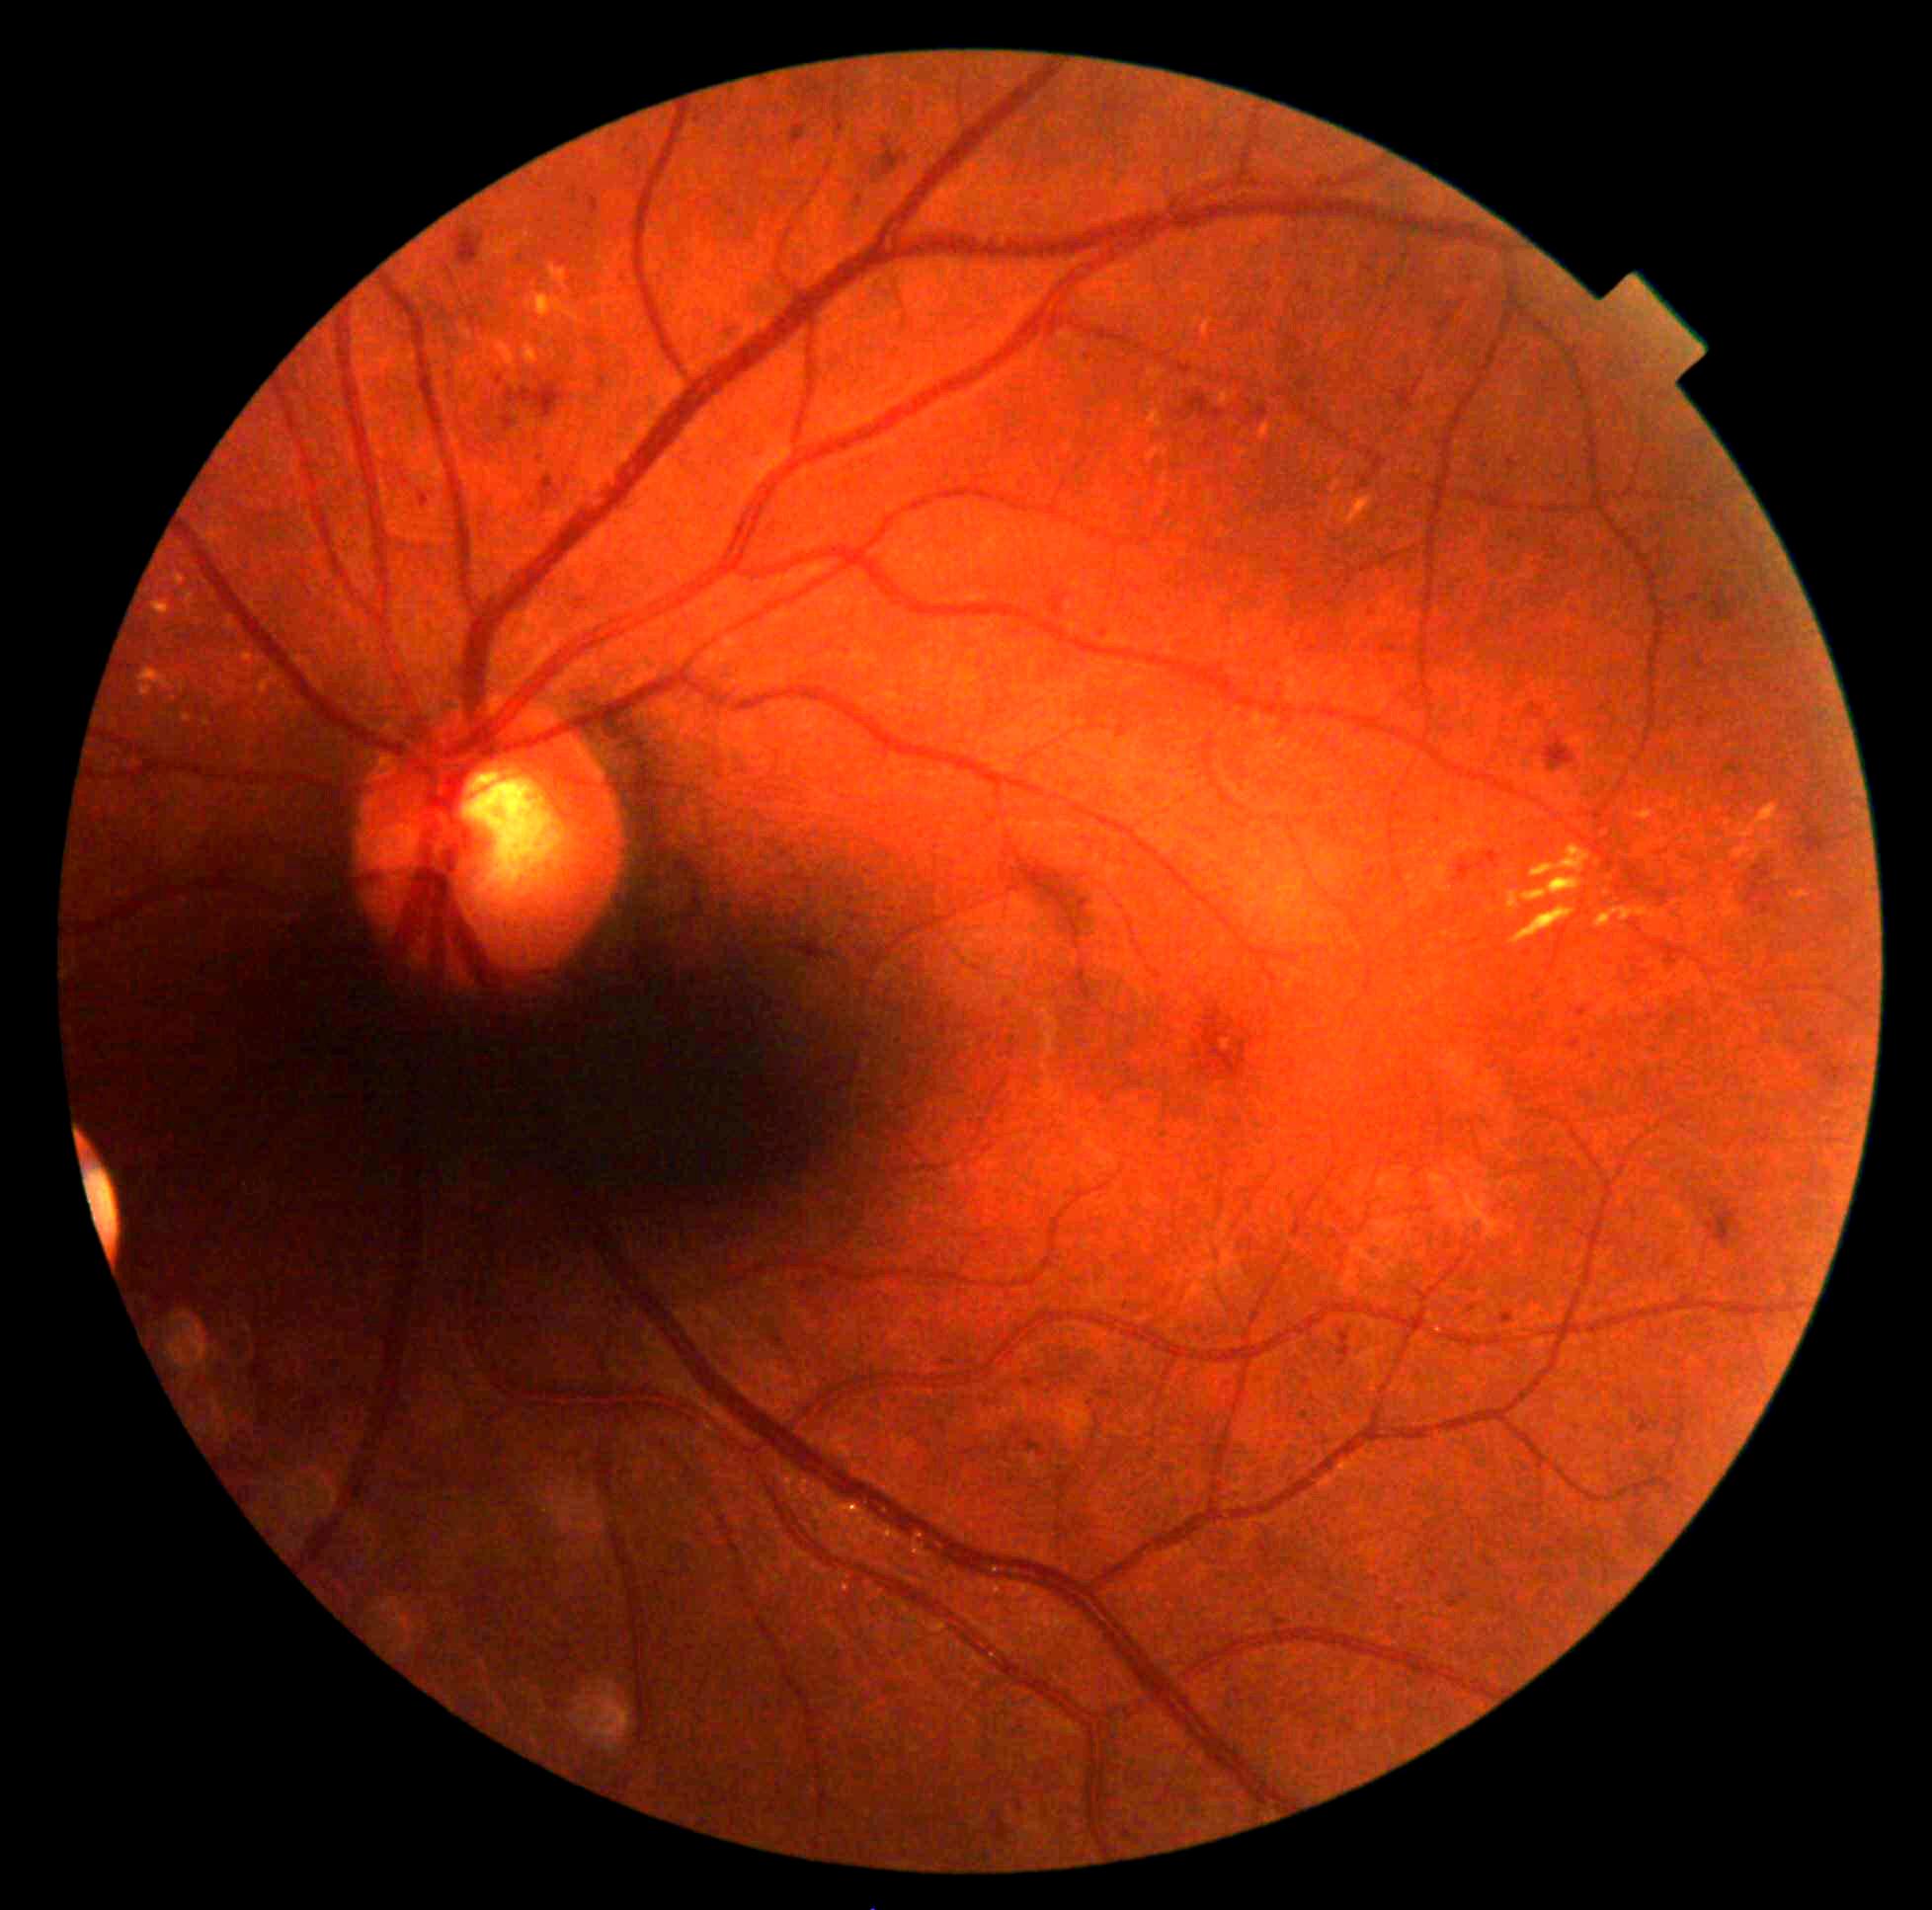

Diabetic retinopathy: moderate non-proliferative diabetic retinopathy (grade 2).